Nonmydriatic fundus photograph:
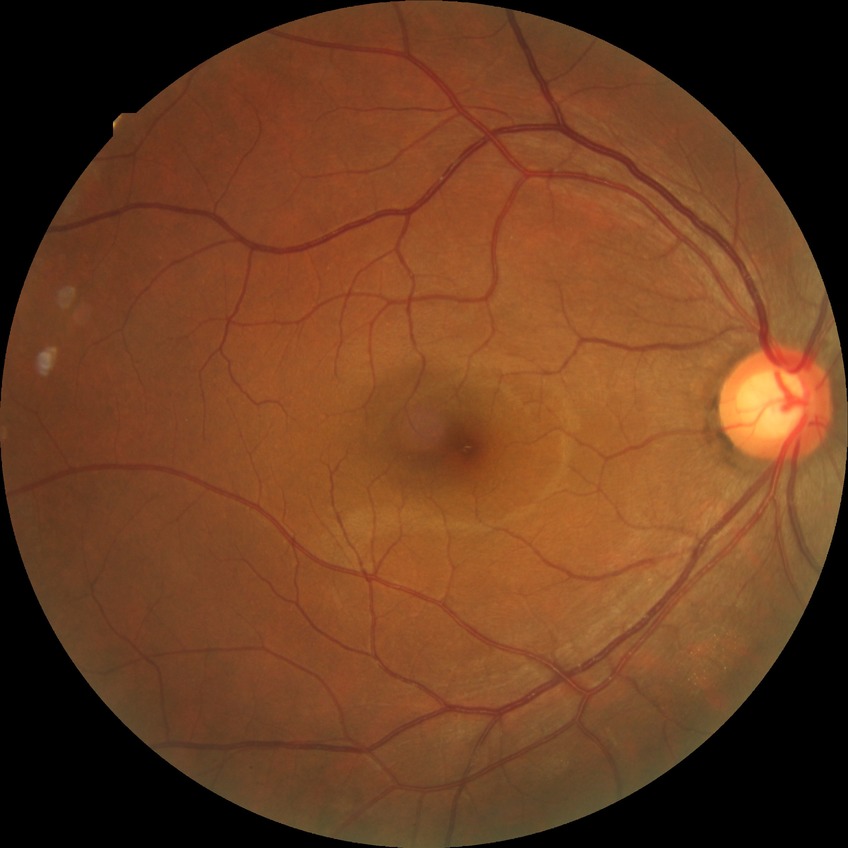

diabetic retinopathy (DR): no diabetic retinopathy (NDR).